848 by 848 pixels: 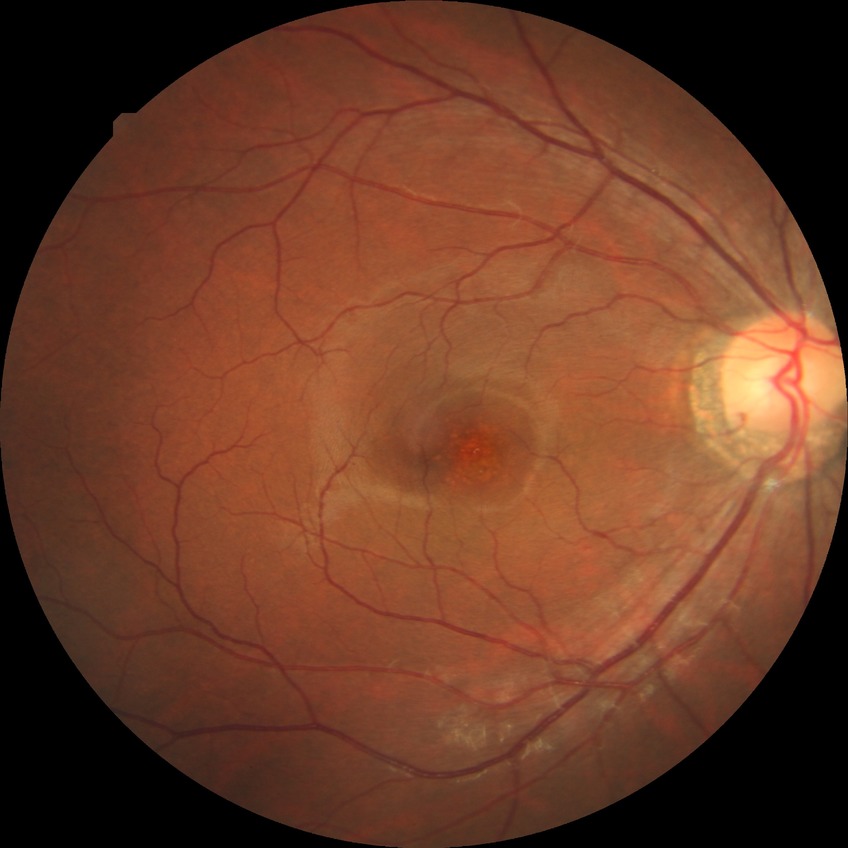
diabetic retinopathy grade: no diabetic retinopathy.